2352 by 1568 pixels; FOV: 45 degrees; color fundus photograph
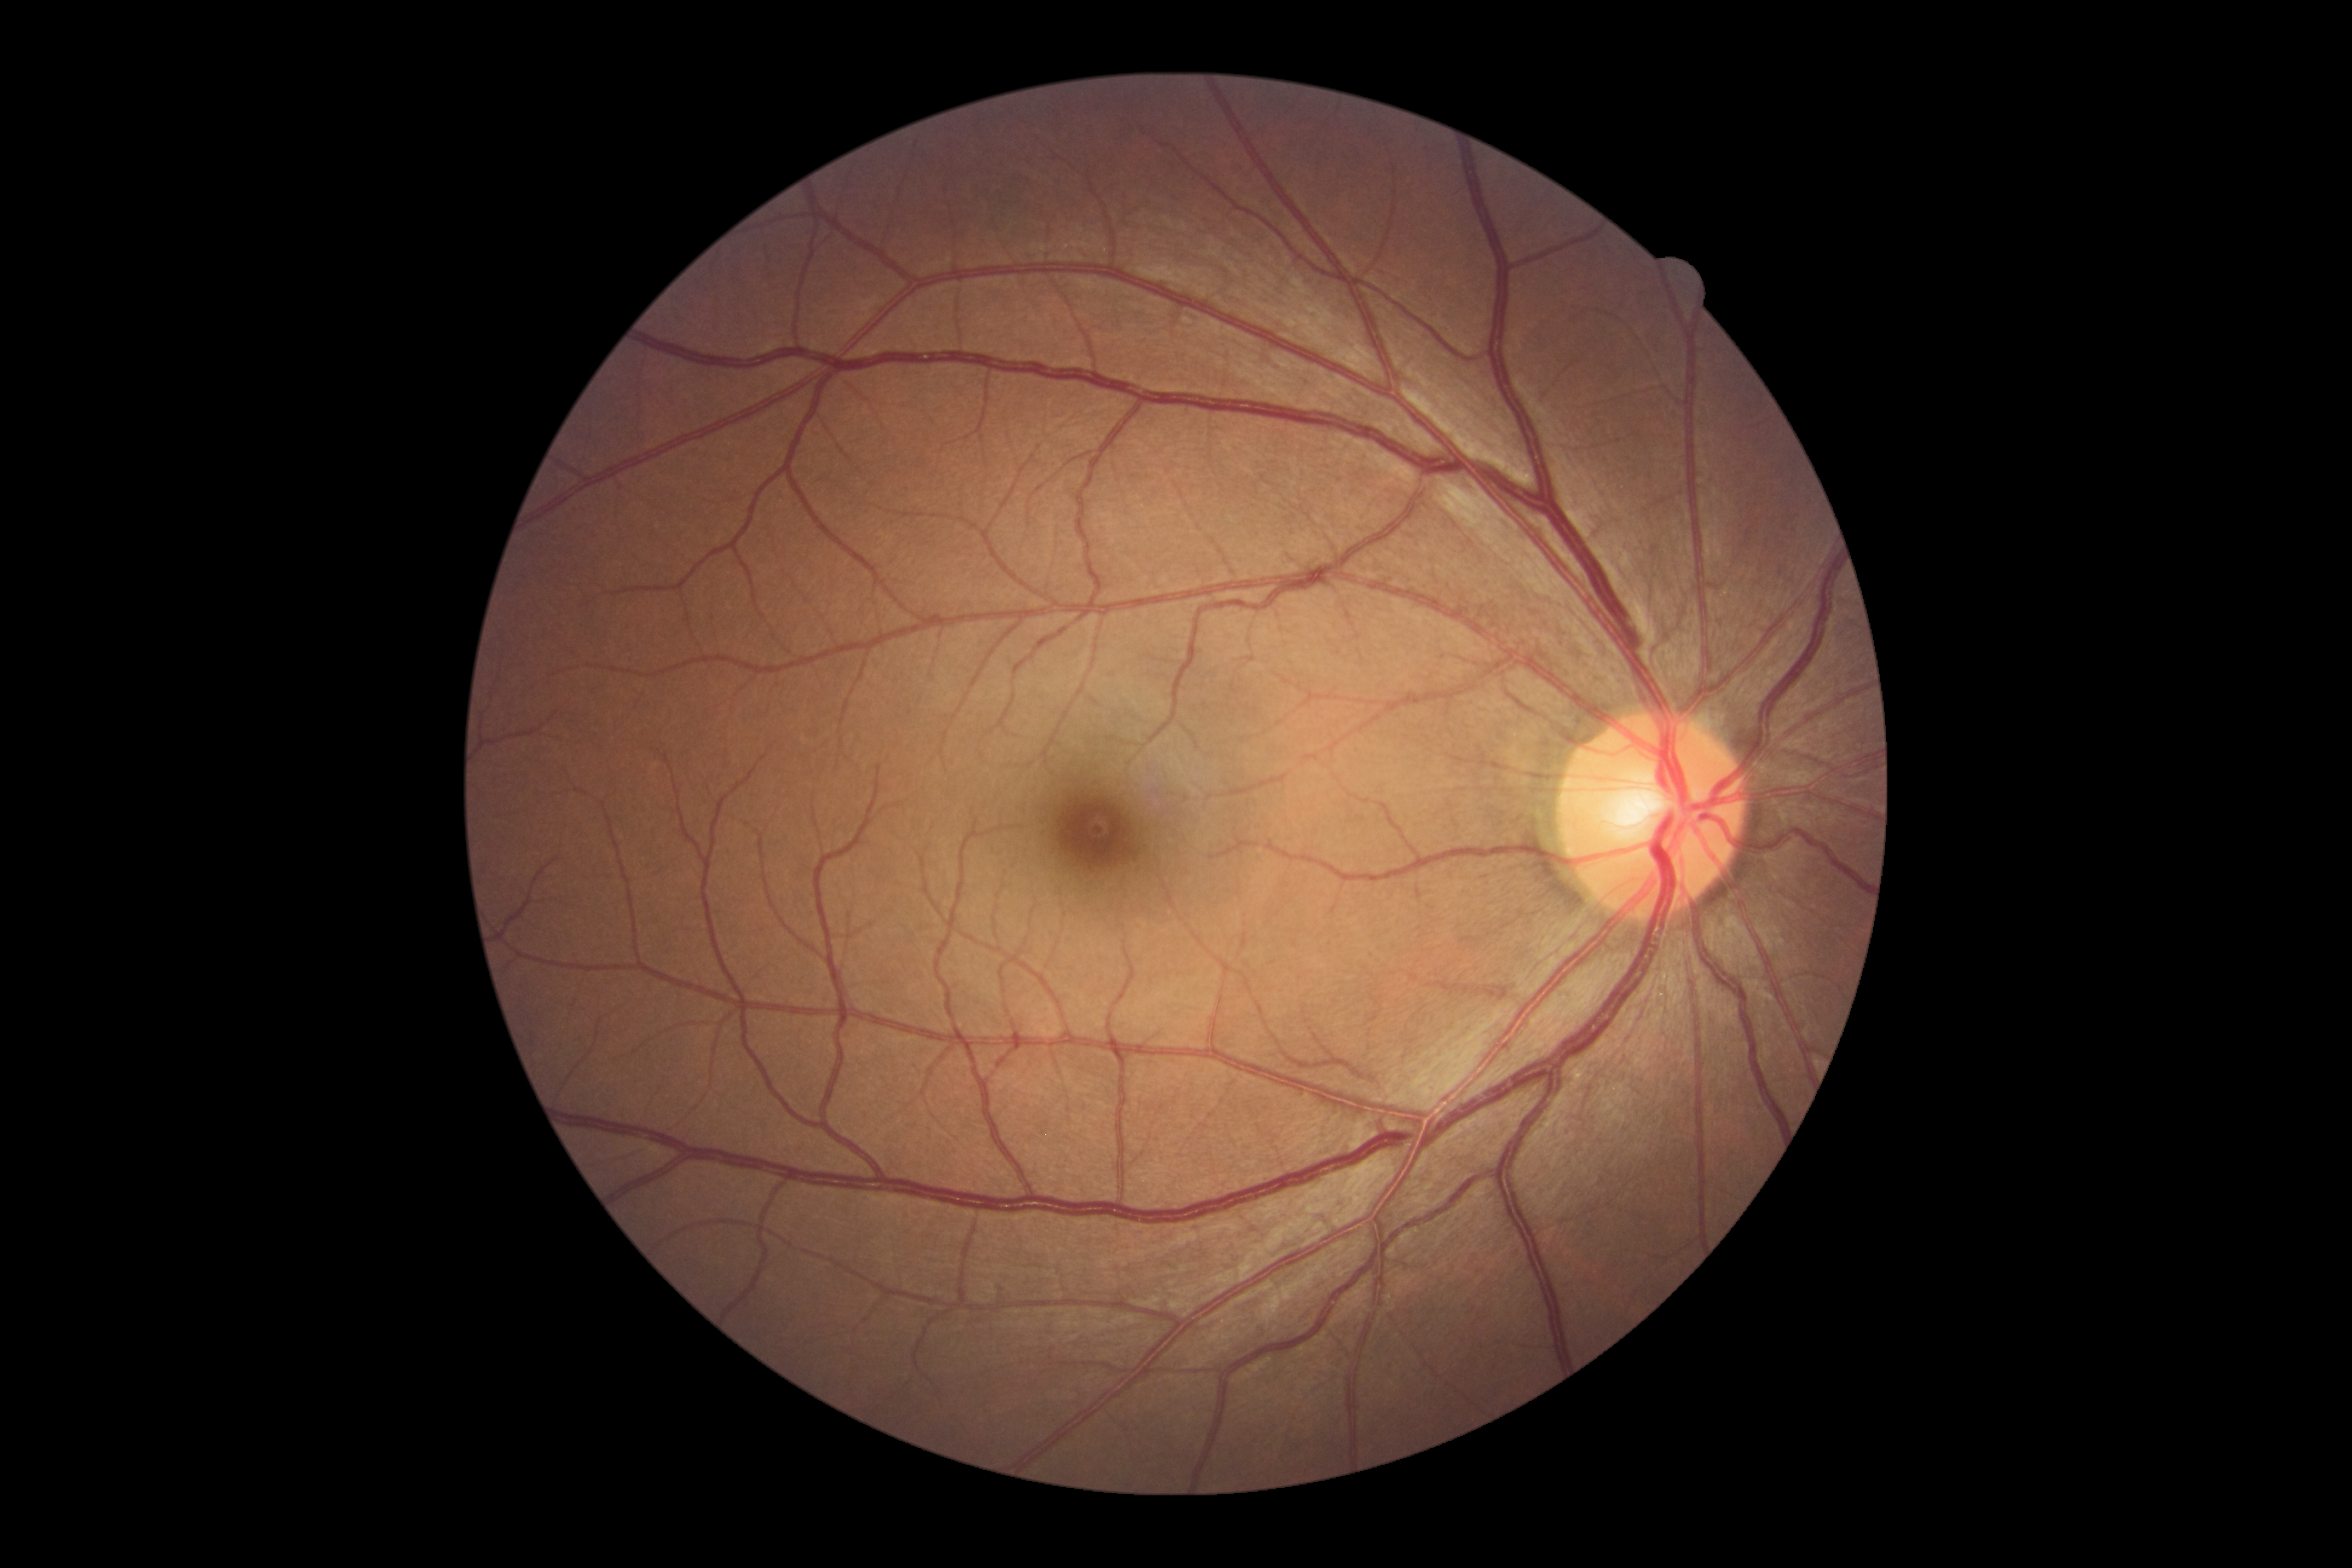 dr_grade: grade 0 (no apparent retinopathy)
dr_impression: no signs of DR